Pediatric wide-field fundus photograph; 640 by 480 pixels
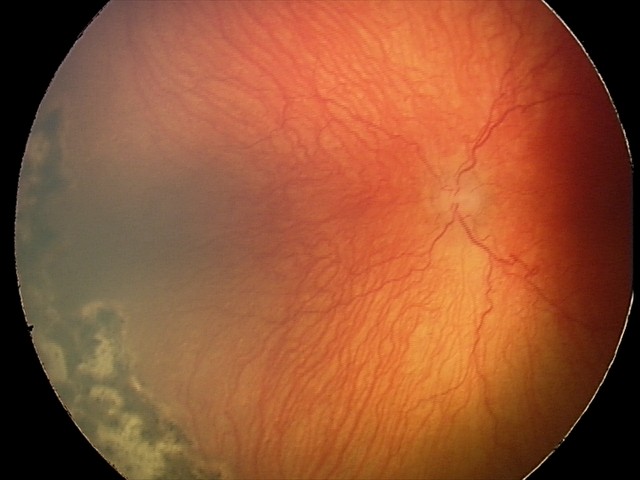
Examination diagnosed as A-ROP (aggressive ROP).